Nonmydriatic fundus photograph, diabetic retinopathy graded by the modified Davis classification:
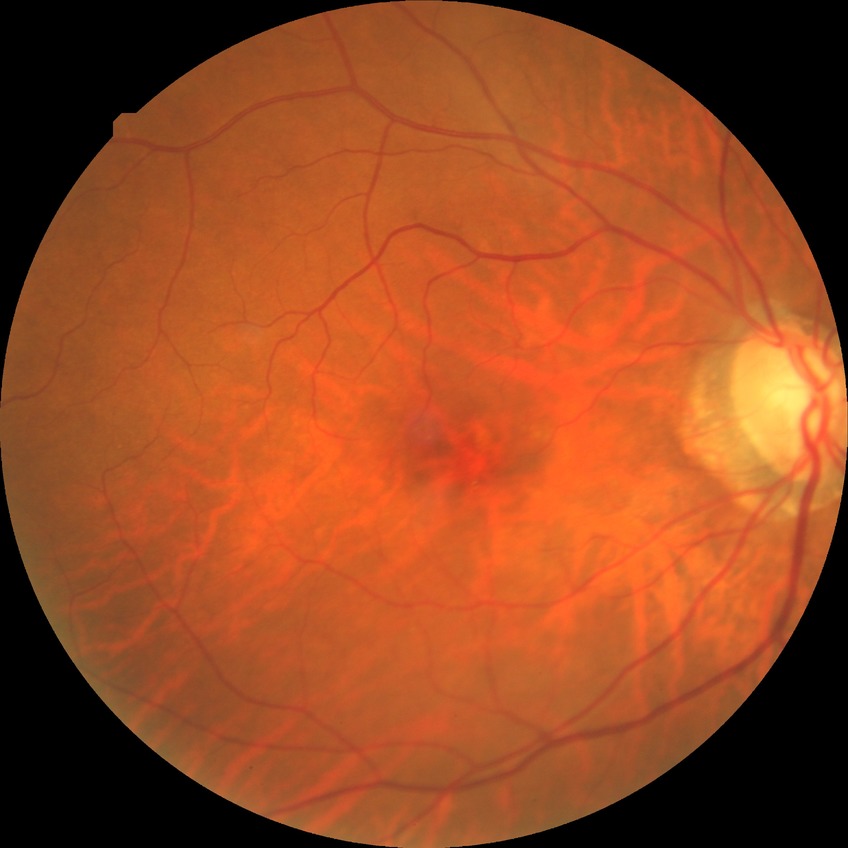

Diabetic retinopathy (DR) is SDR (simple diabetic retinopathy).